Diabetic retinopathy graded by the modified Davis classification — 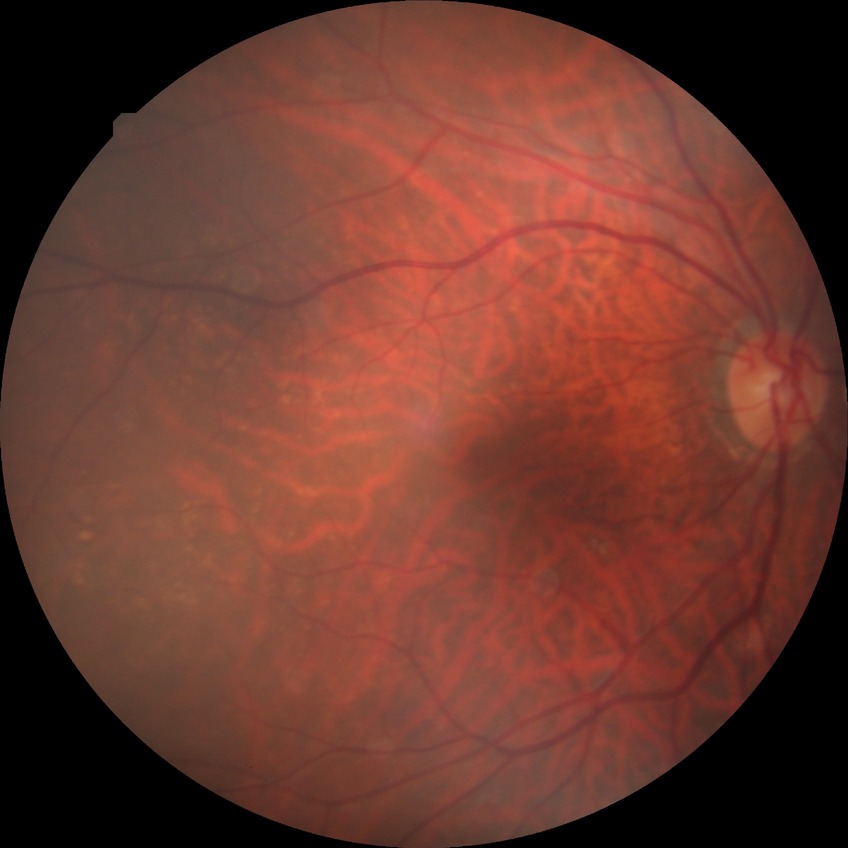

{"davis_grade": "no diabetic retinopathy"}